Graded on the modified Davis scale · nonmydriatic fundus photograph — 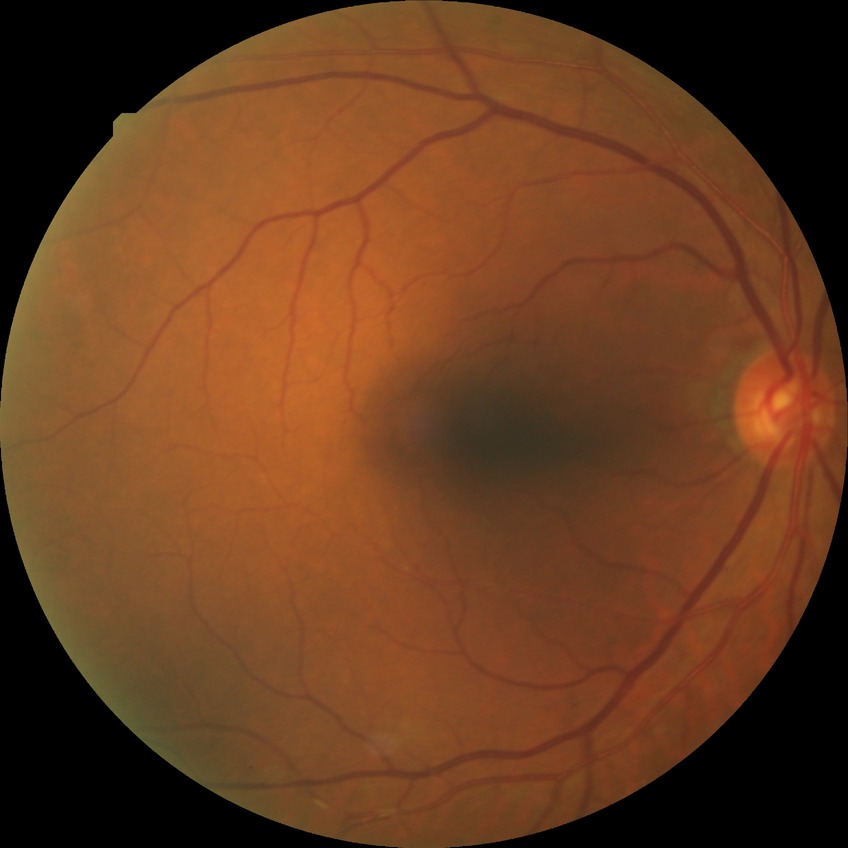
The retinopathy is classified as non-proliferative diabetic retinopathy. Diabetic retinopathy (DR): PPDR (pre-proliferative diabetic retinopathy).